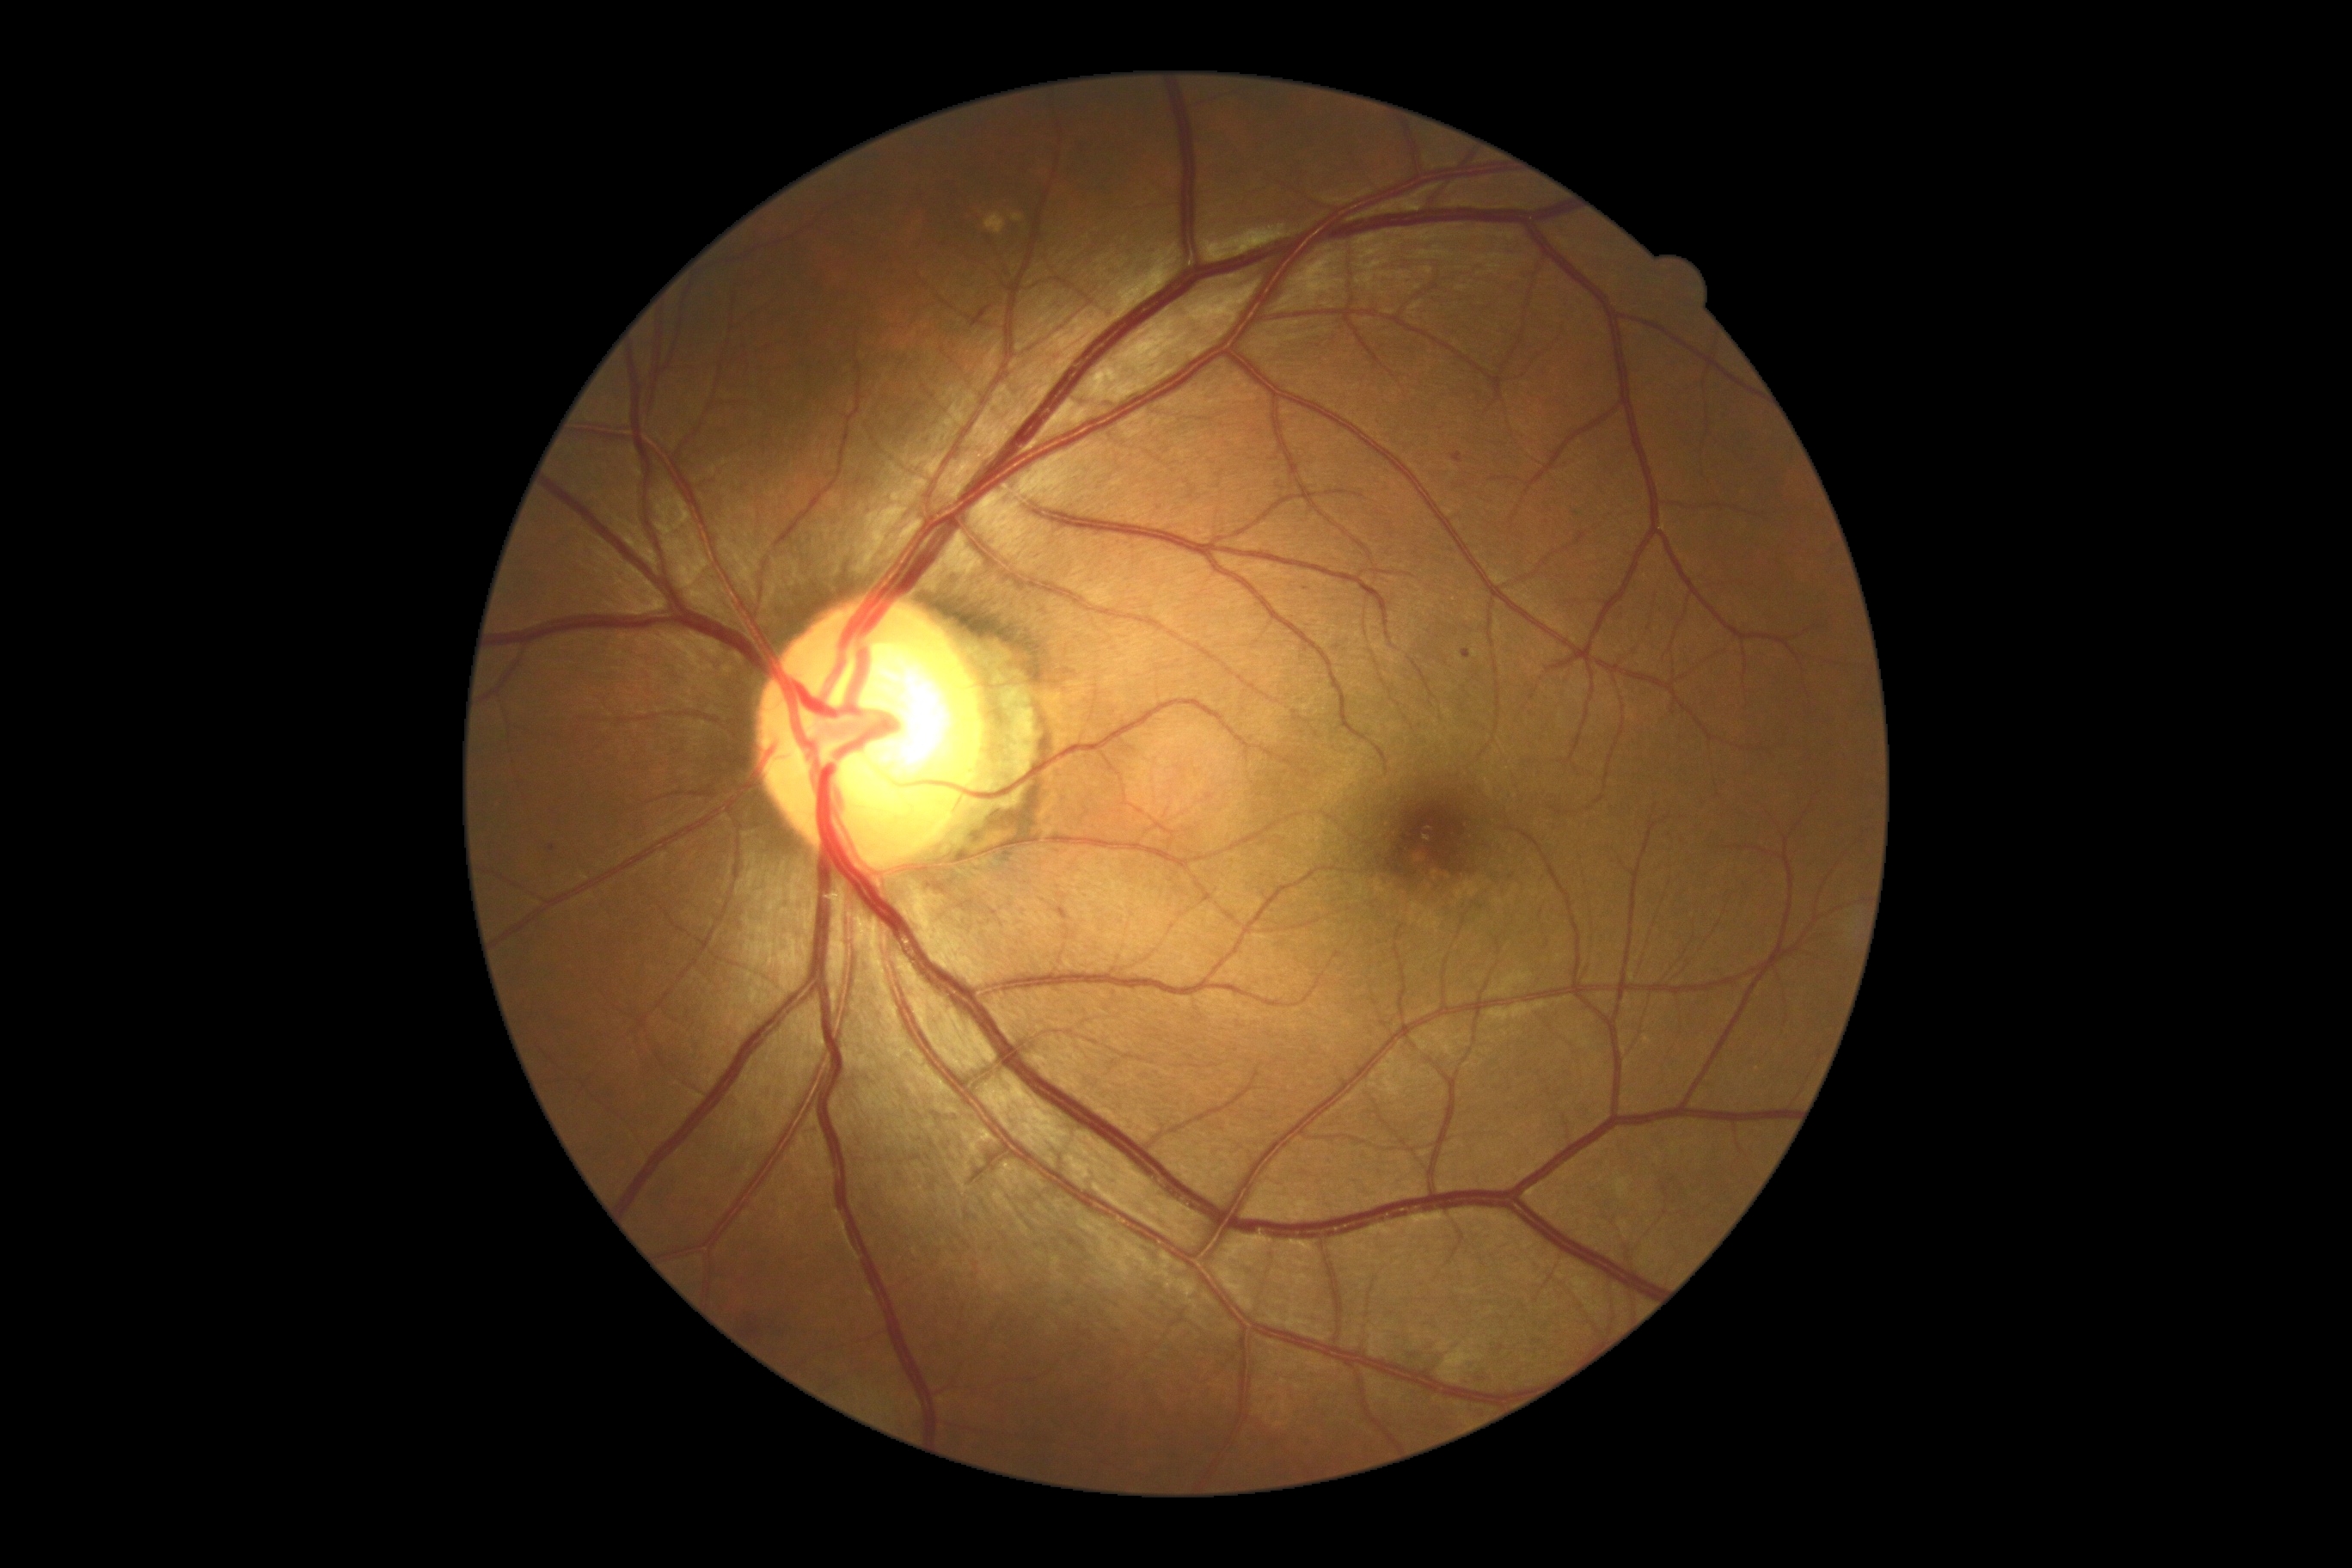
Diabetic retinopathy: mild NPDR (grade 1).
Microaneurysms identified at 1452,453,1464,463; 1461,651,1473,659.
Microaneurysms (small, approximate centers) near 552/848.
No soft exudates identified.
No hemorrhages identified.
No hard exudates identified.